45° field of view.
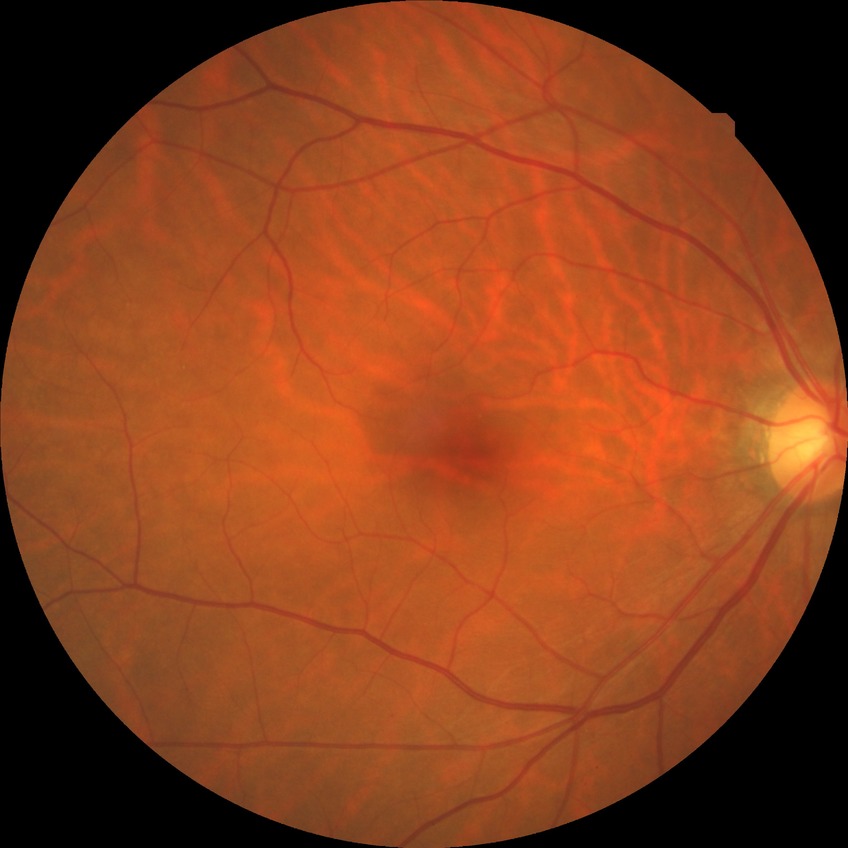
Davis stage is NDR.